45° field of view, 2048x1536px: 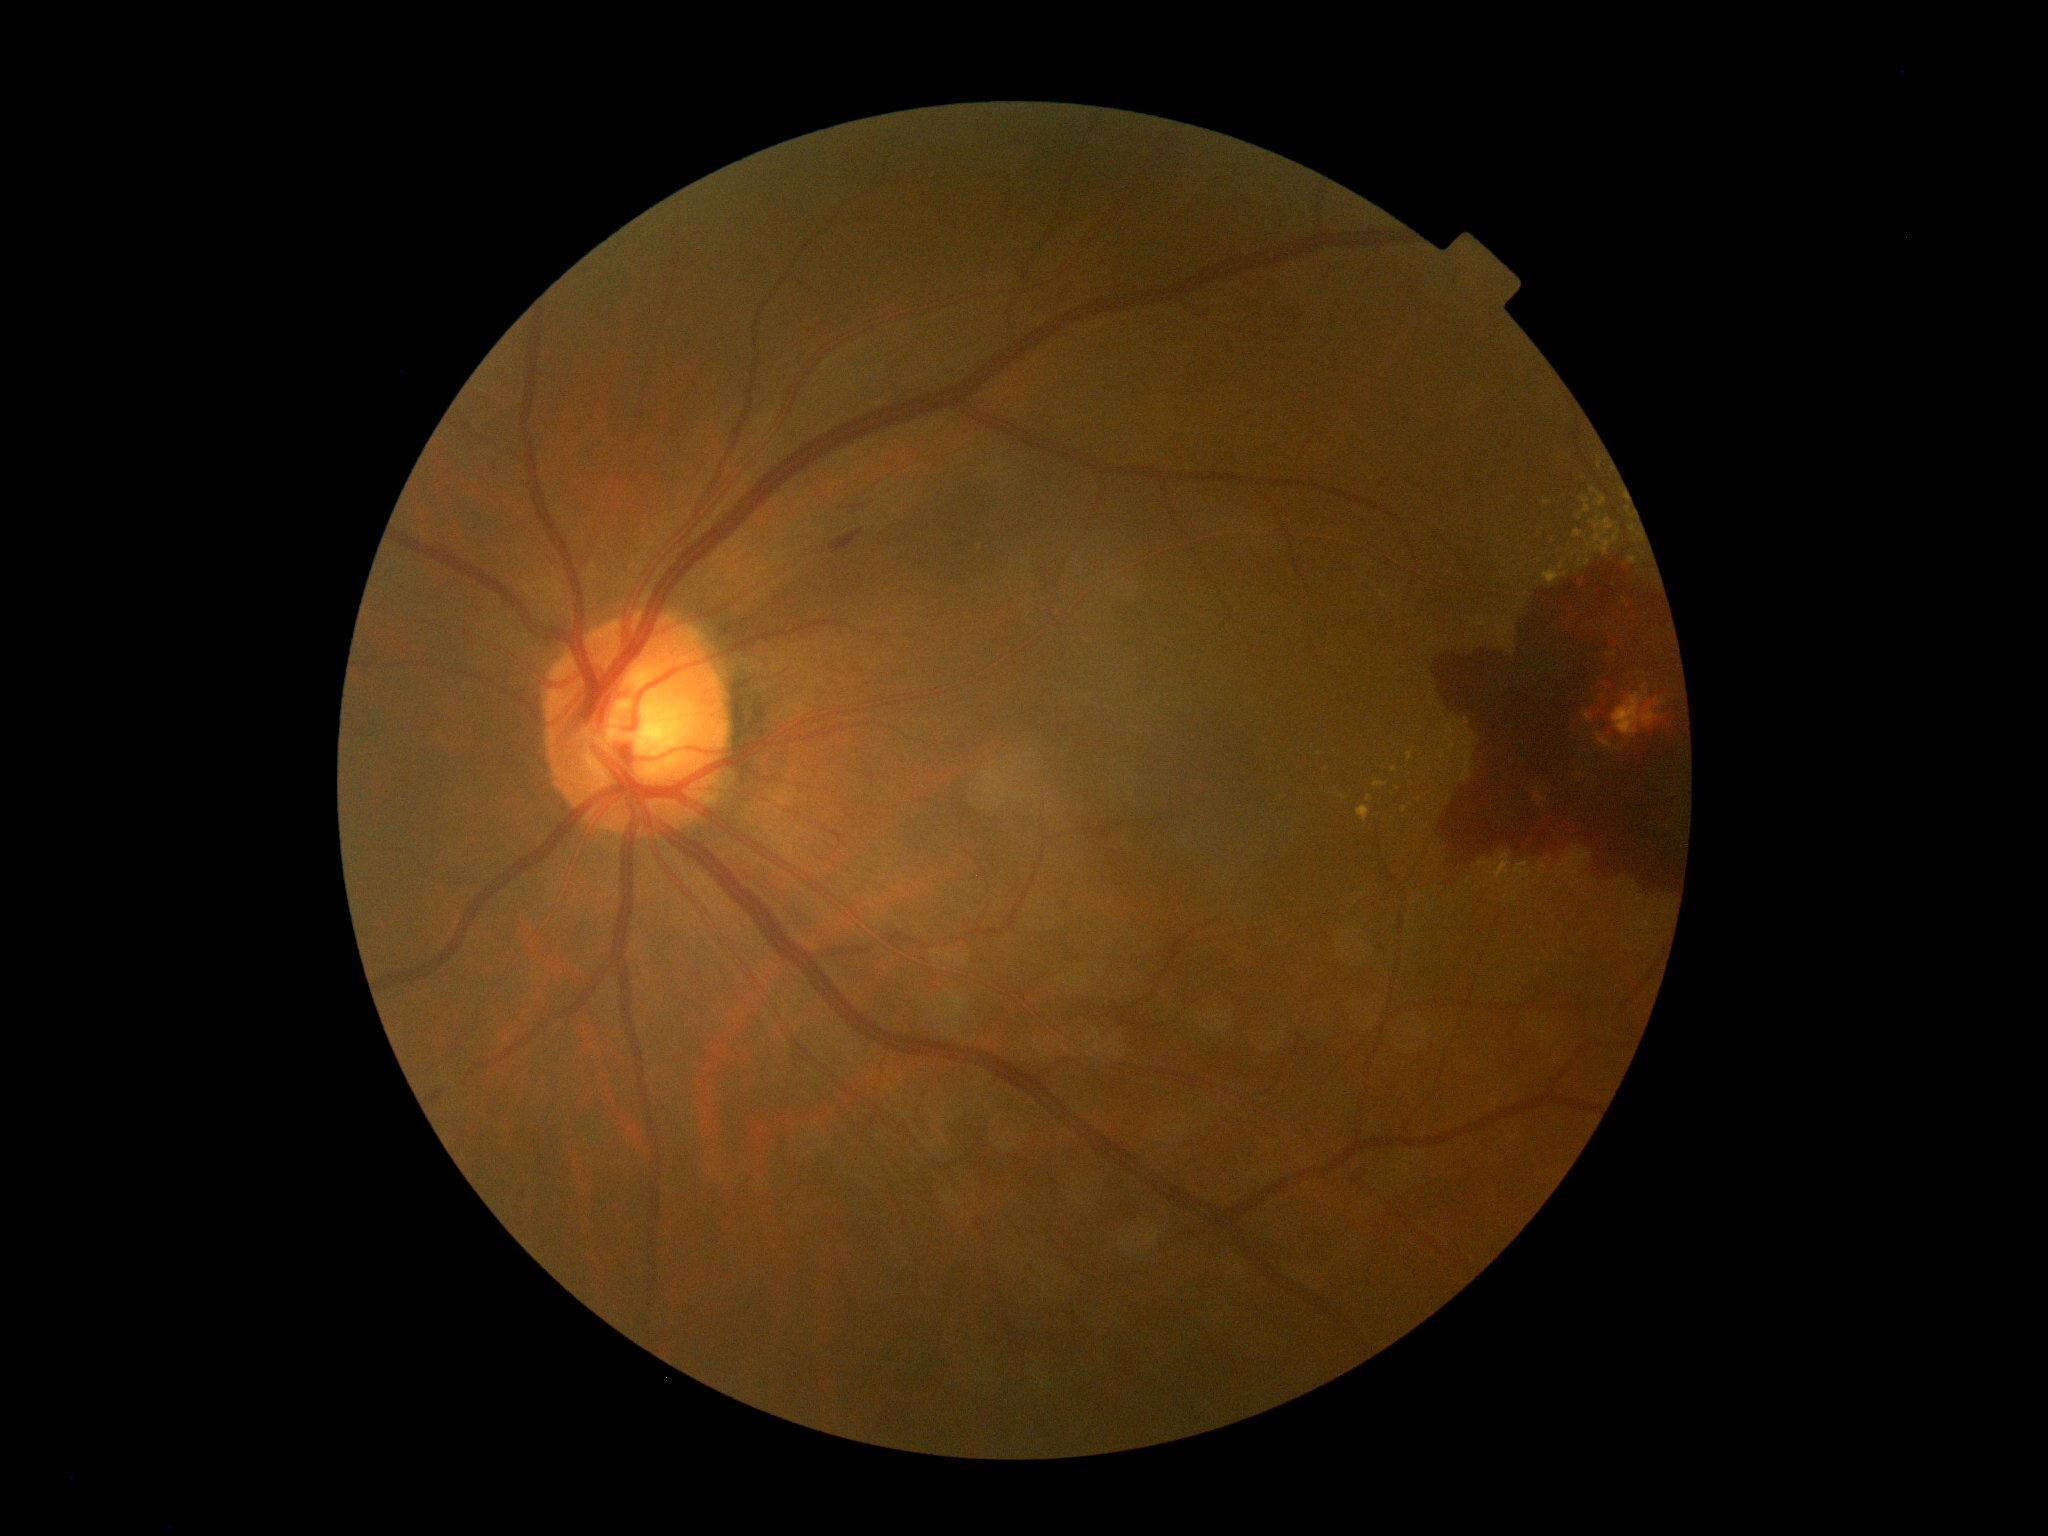 DR stage = 4/4